Image size 2228x1652
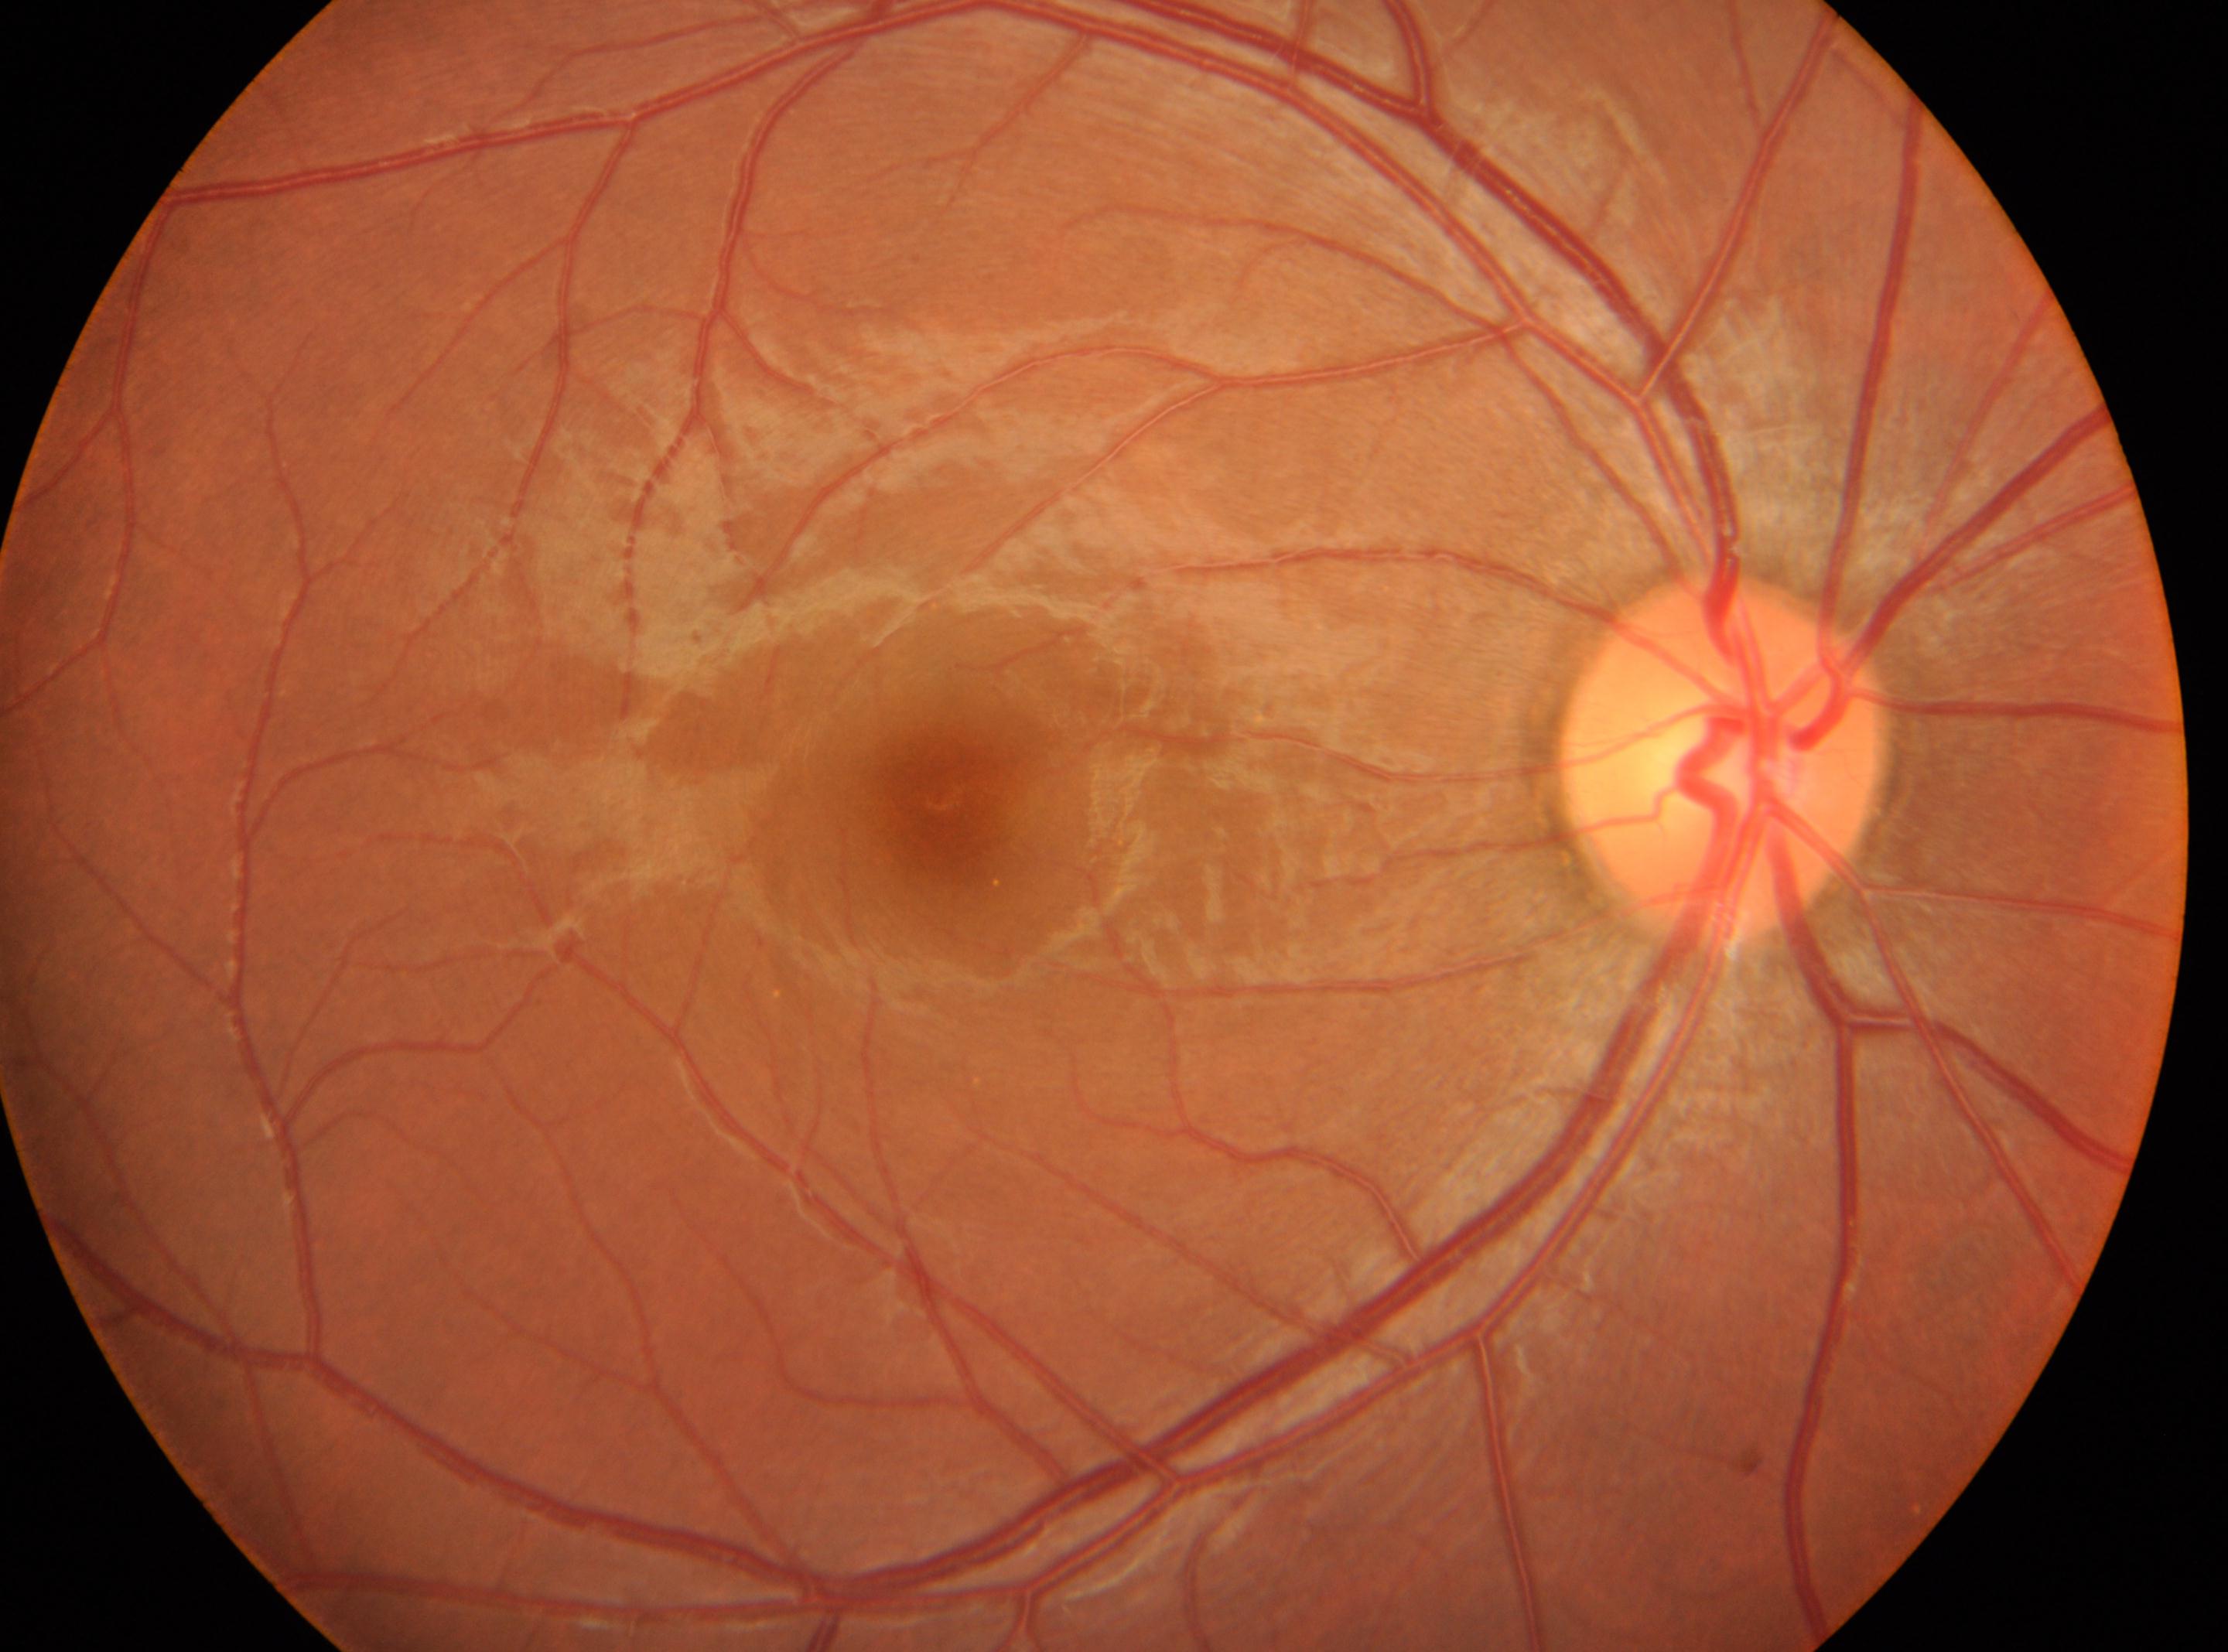
DR stage = grade 0 (no apparent retinopathy) | optic disc center = x=1717, y=759 | macular center = x=936, y=798 | eye = OD.